Fundus photo, image size 2212x1672, 45° FOV
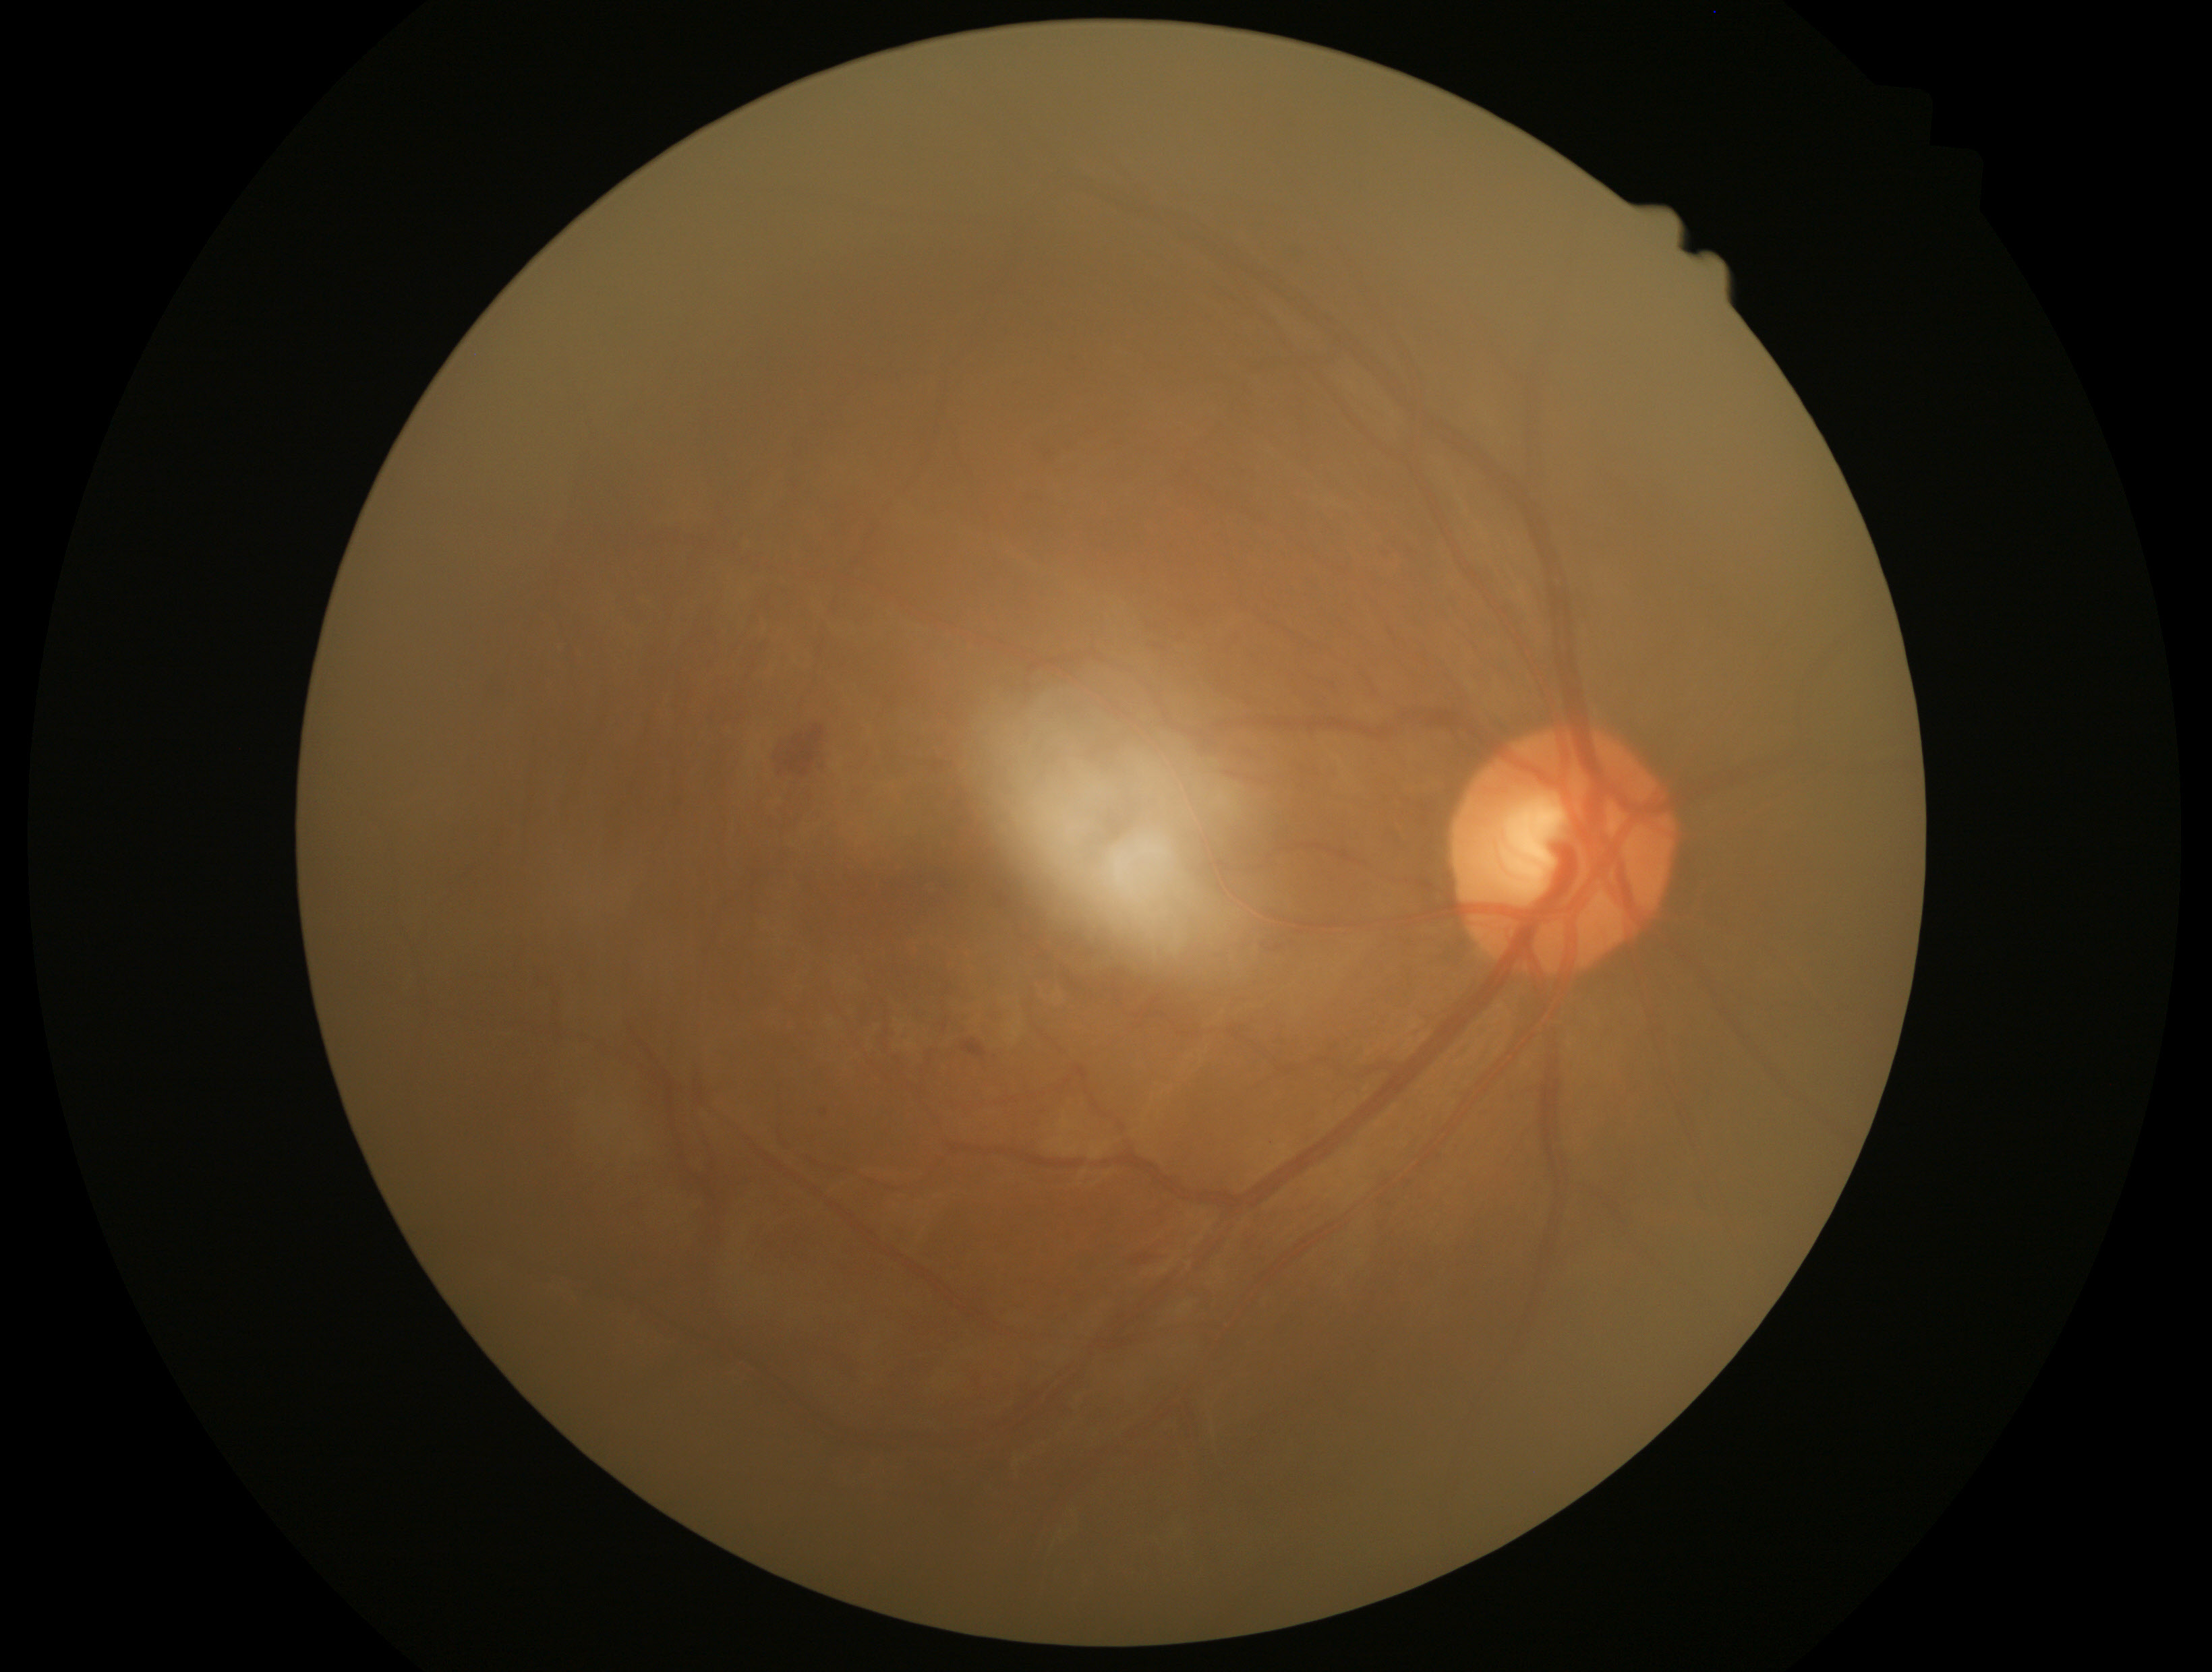
Diabetic retinopathy (DR) is grade 2. The retinopathy is classified as non-proliferative diabetic retinopathy.